Pediatric retinal photograph (wide-field) · Natus RetCam Envision, 130° FOV:
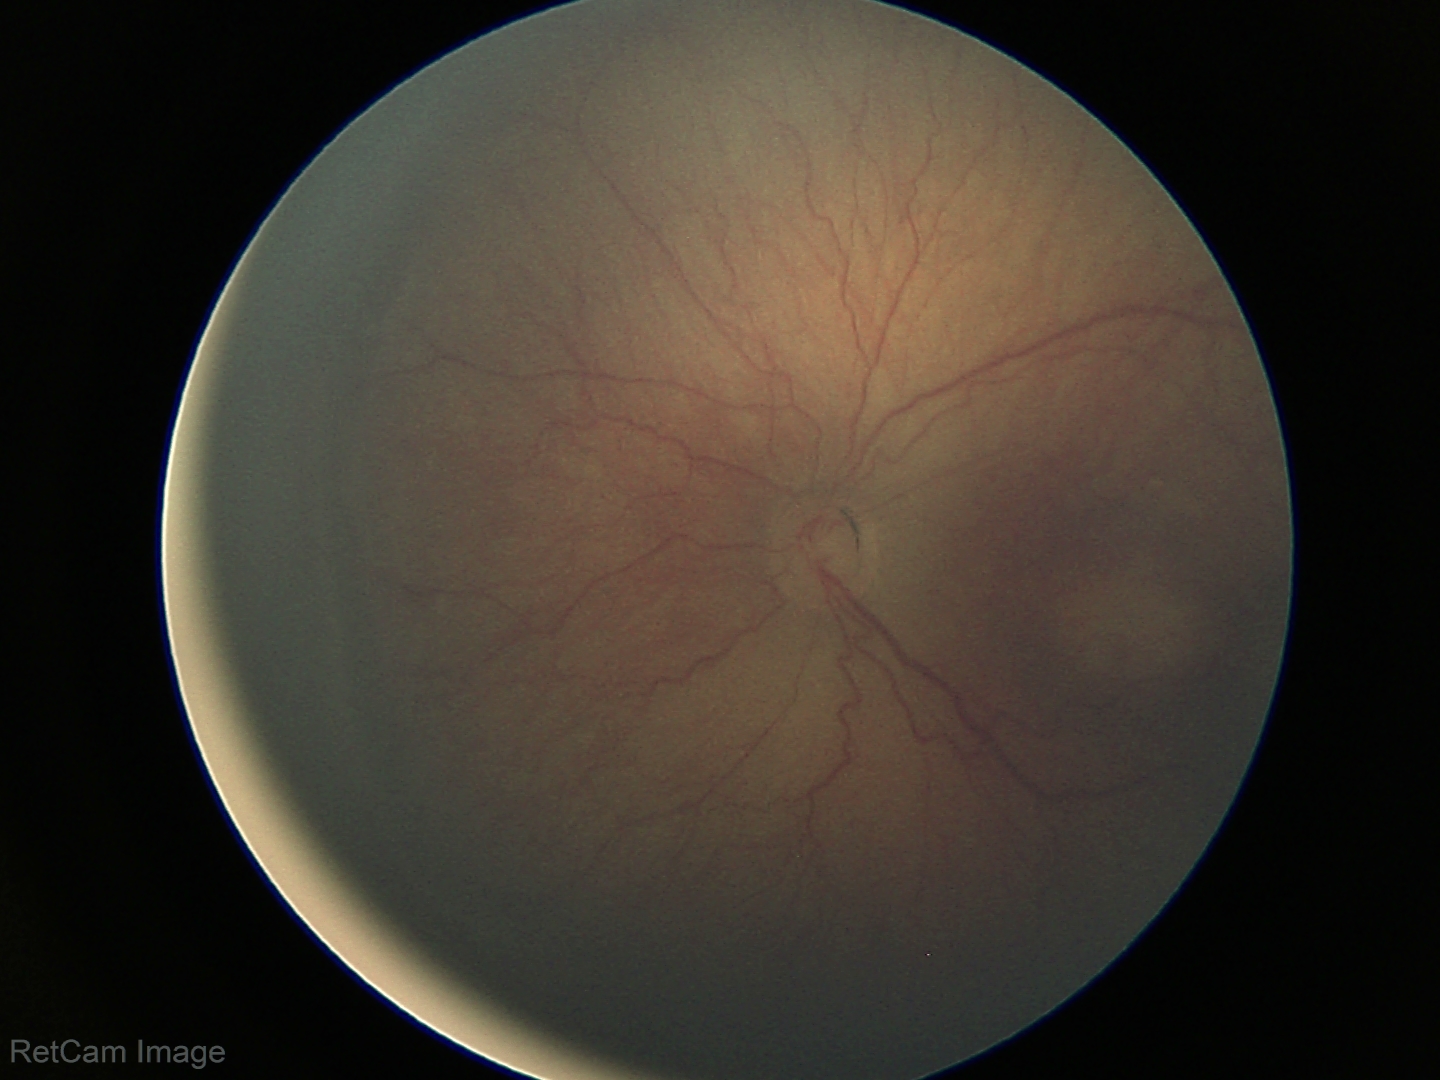

Assessment: no plus disease; ROP stage 3.